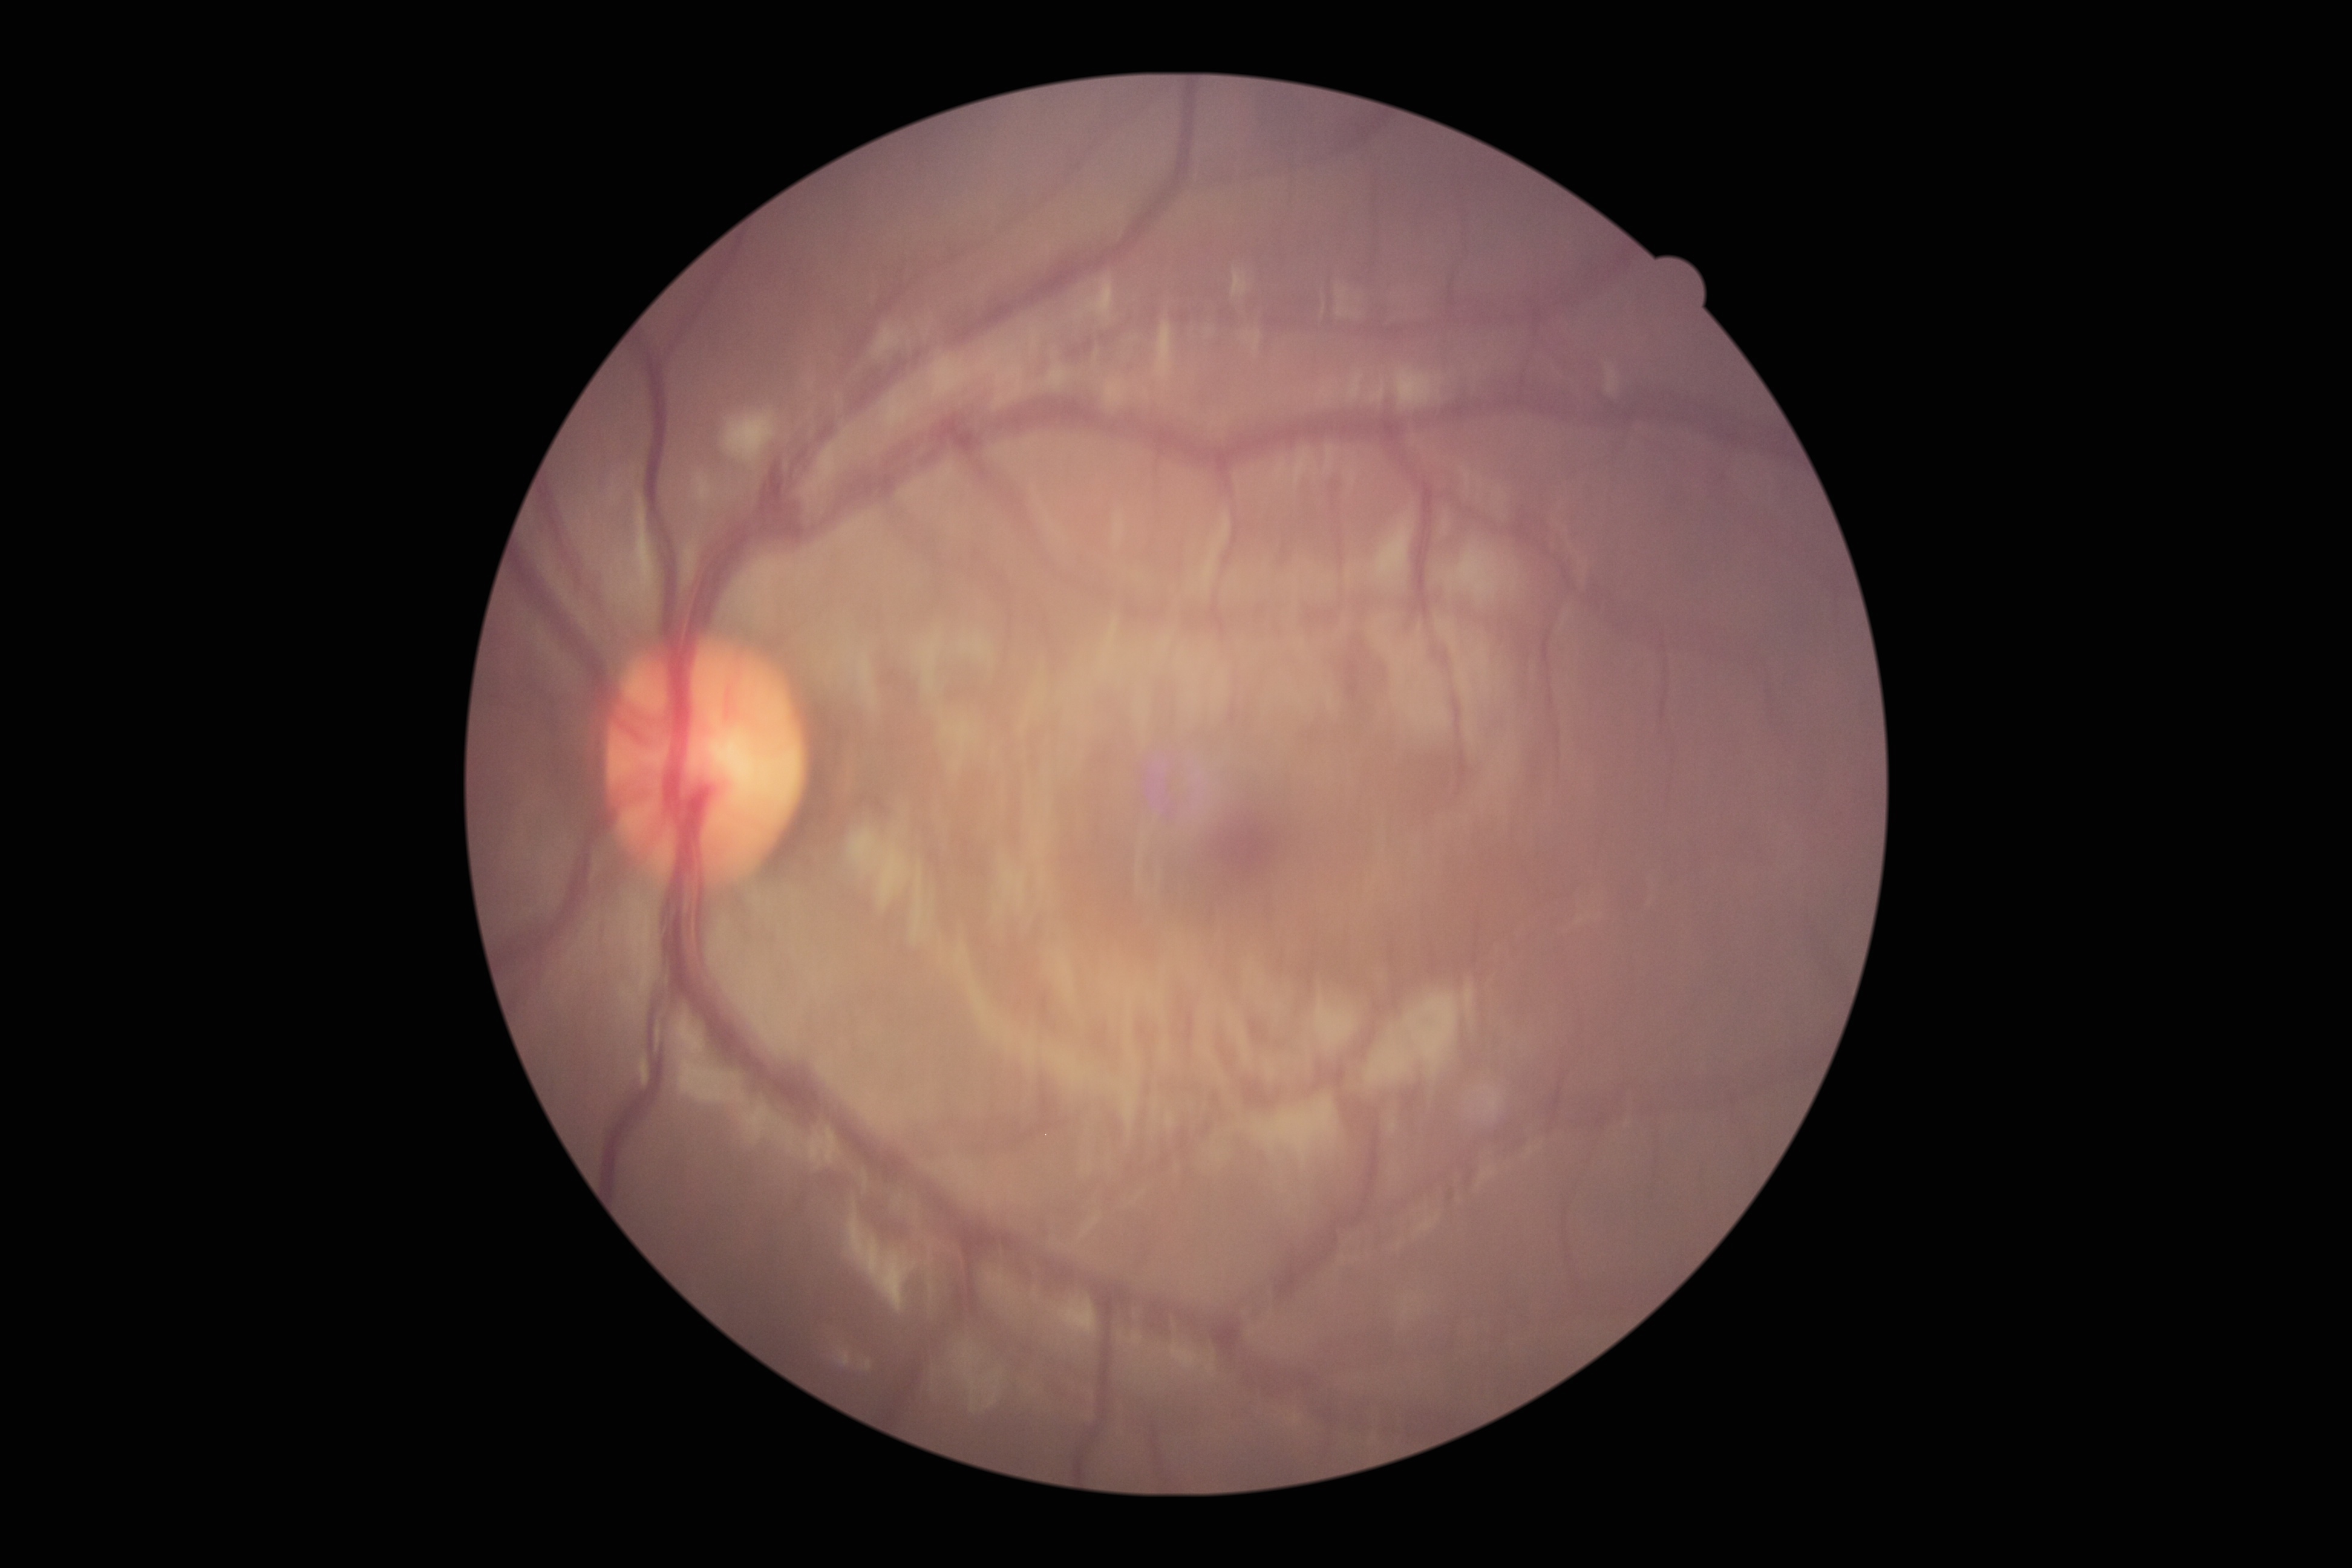
DR severity: 0.